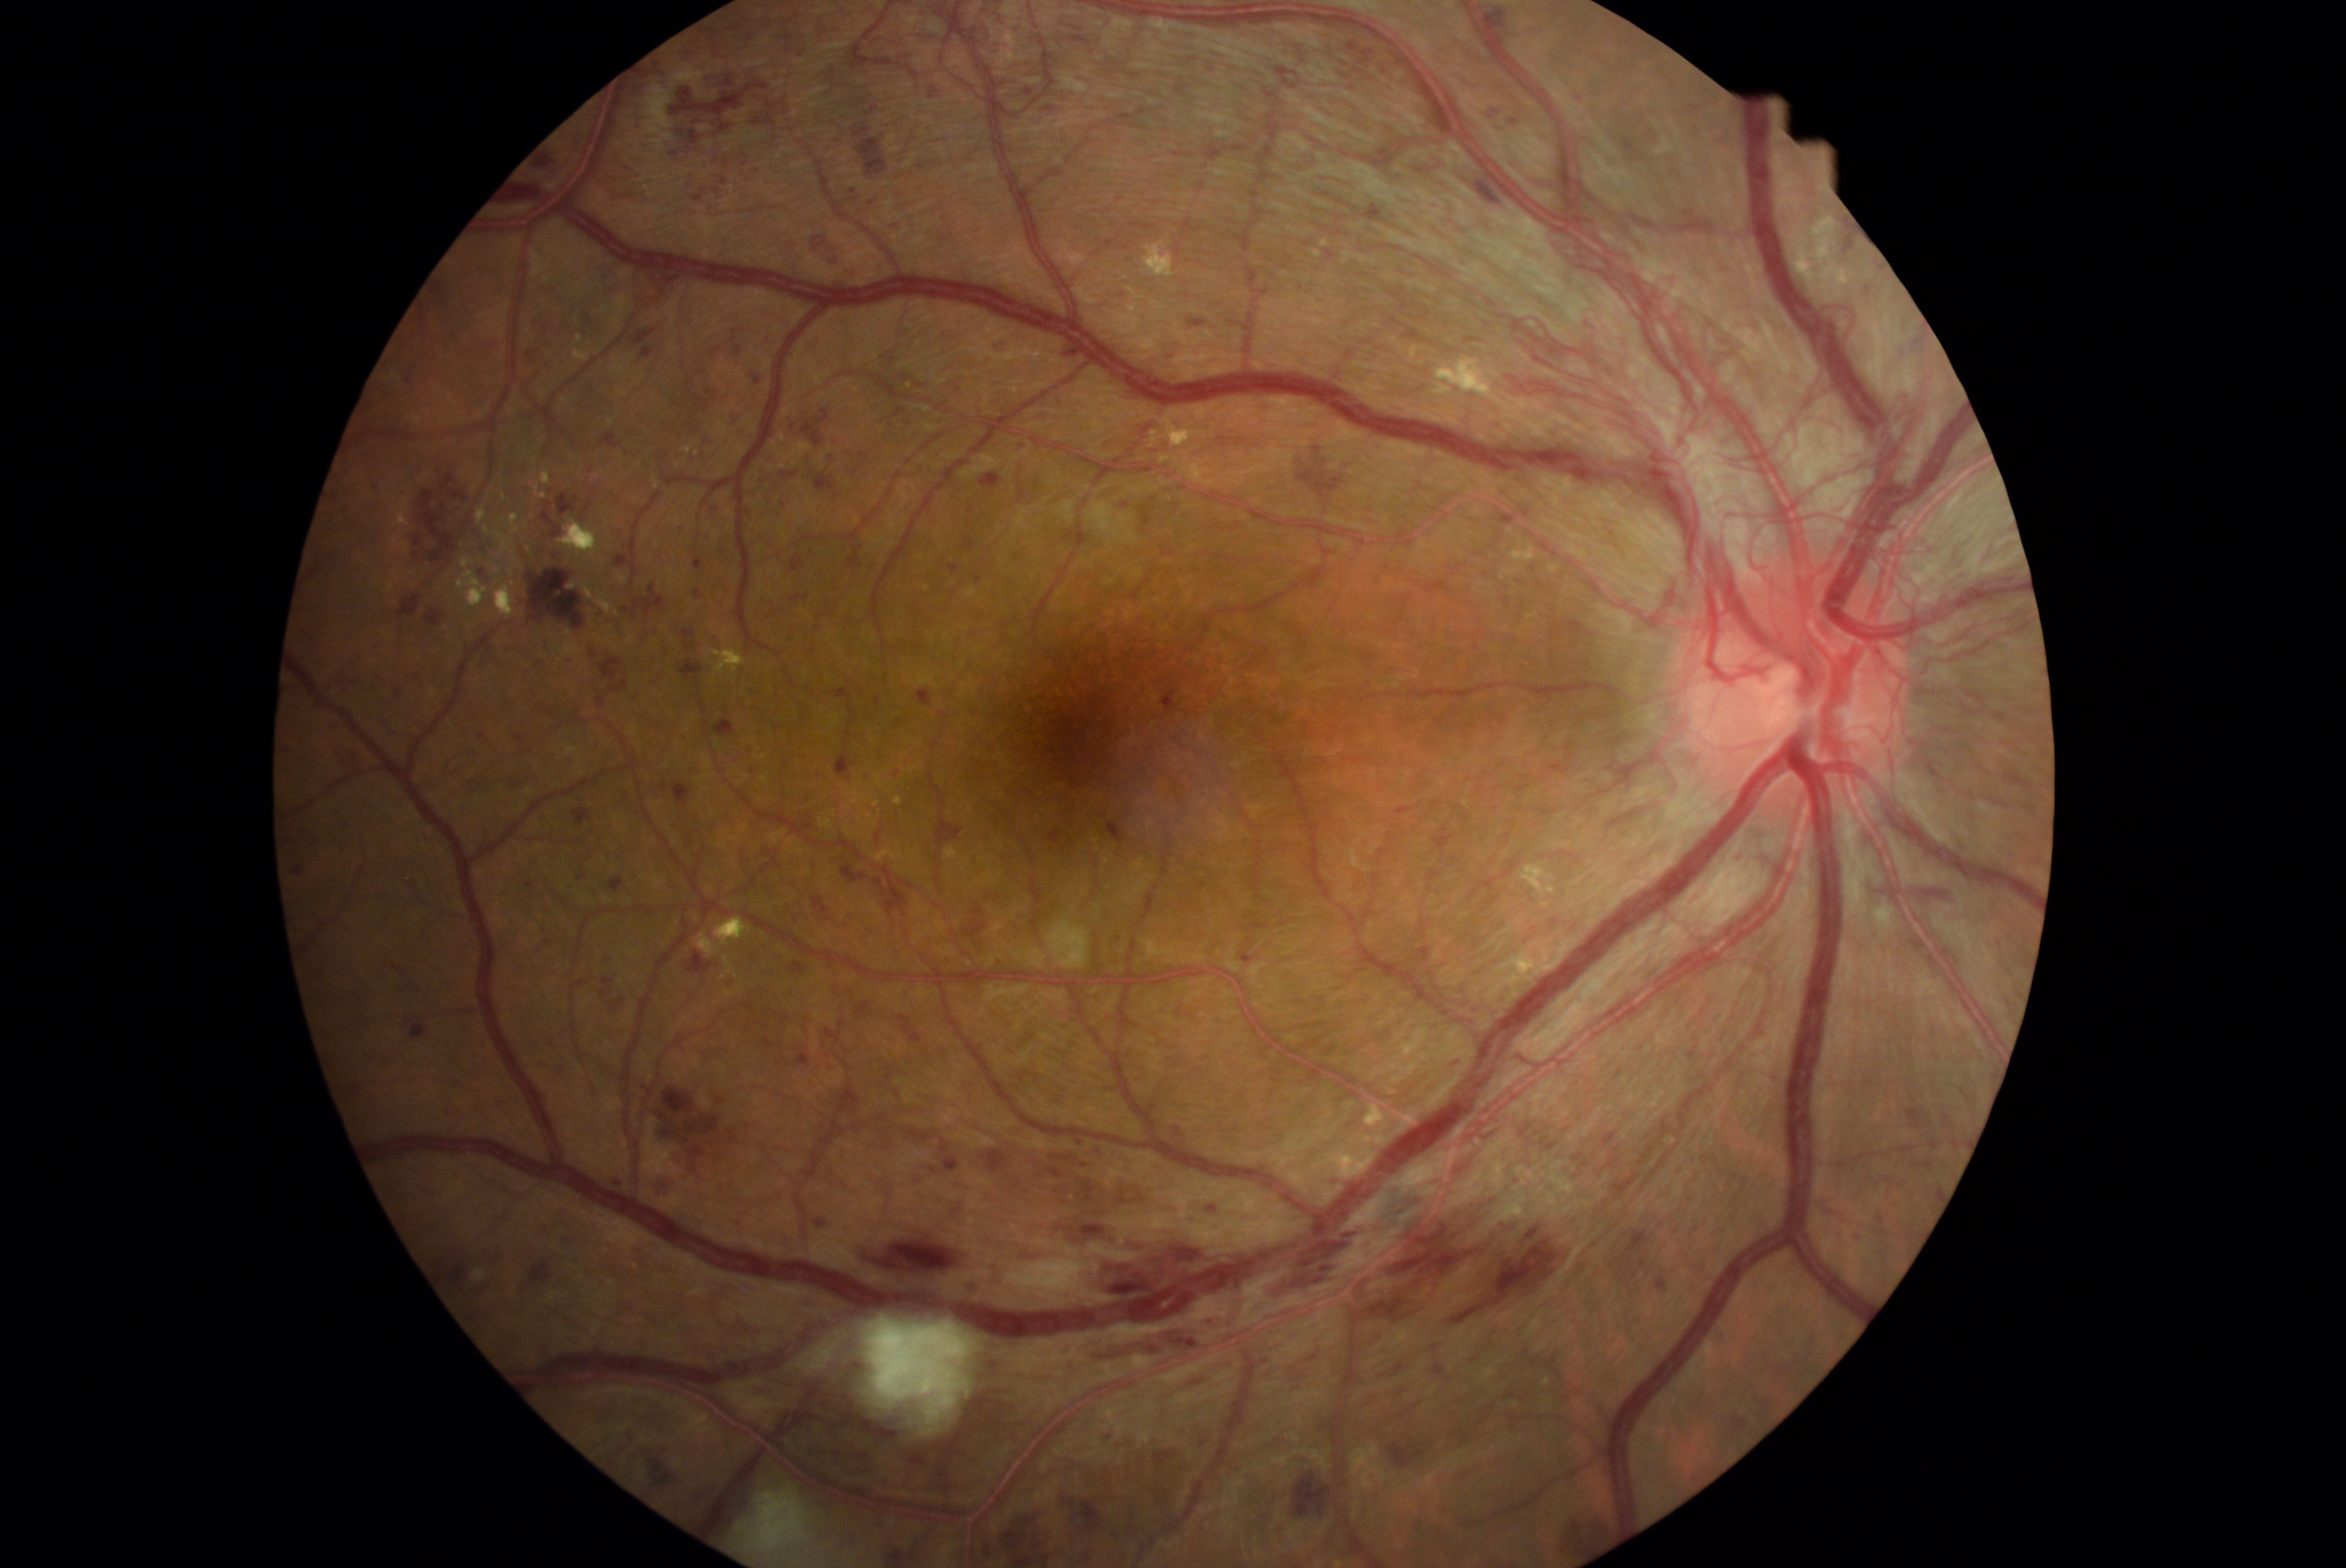
partial: true
dr_grade: 4
dr_grade_name: PDR
lesions:
  ex:
    - [713,648,747,675]
    - [559,520,601,559]
    - [537,485,548,499]
    - [697,934,721,957]
    - [1523,865,1558,896]
    - [821,819,833,829]
    - [895,797,904,805]
    - [1839,267,1854,286]
    - [1796,264,1812,278]
    - [685,448,694,454]
    - [1144,241,1175,278]
    - [484,514,521,564]
    - [478,499,490,526]
    - [496,521,504,528]
    - [945,848,959,860]
    - [1489,951,1541,1001]
  ex_small:
    - pt(581, 339)
    - pt(1118, 301)
    - pt(697, 453)
    - pt(871, 815)
  he:
    - [1296,280,1310,294]
    - [1770,1360,1795,1382]
    - [1116,107,1152,126]
    - [1851,1233,1867,1244]
    - [1161,688,1178,713]
    - [805,860,821,877]
    - [419,313,427,330]
    - [578,871,589,880]
    - [1864,868,1956,904]
    - [637,633,648,641]
    - [1390,800,1412,815]
    - [887,769,906,782]
    - [642,1443,677,1498]
    - [702,532,713,539]
    - [857,139,888,175]
    - [655,448,678,463]
    - [965,1119,1163,1211]
    - [855,1363,862,1371]
    - [2022,949,2027,957]
  he_small:
    - pt(472, 783)